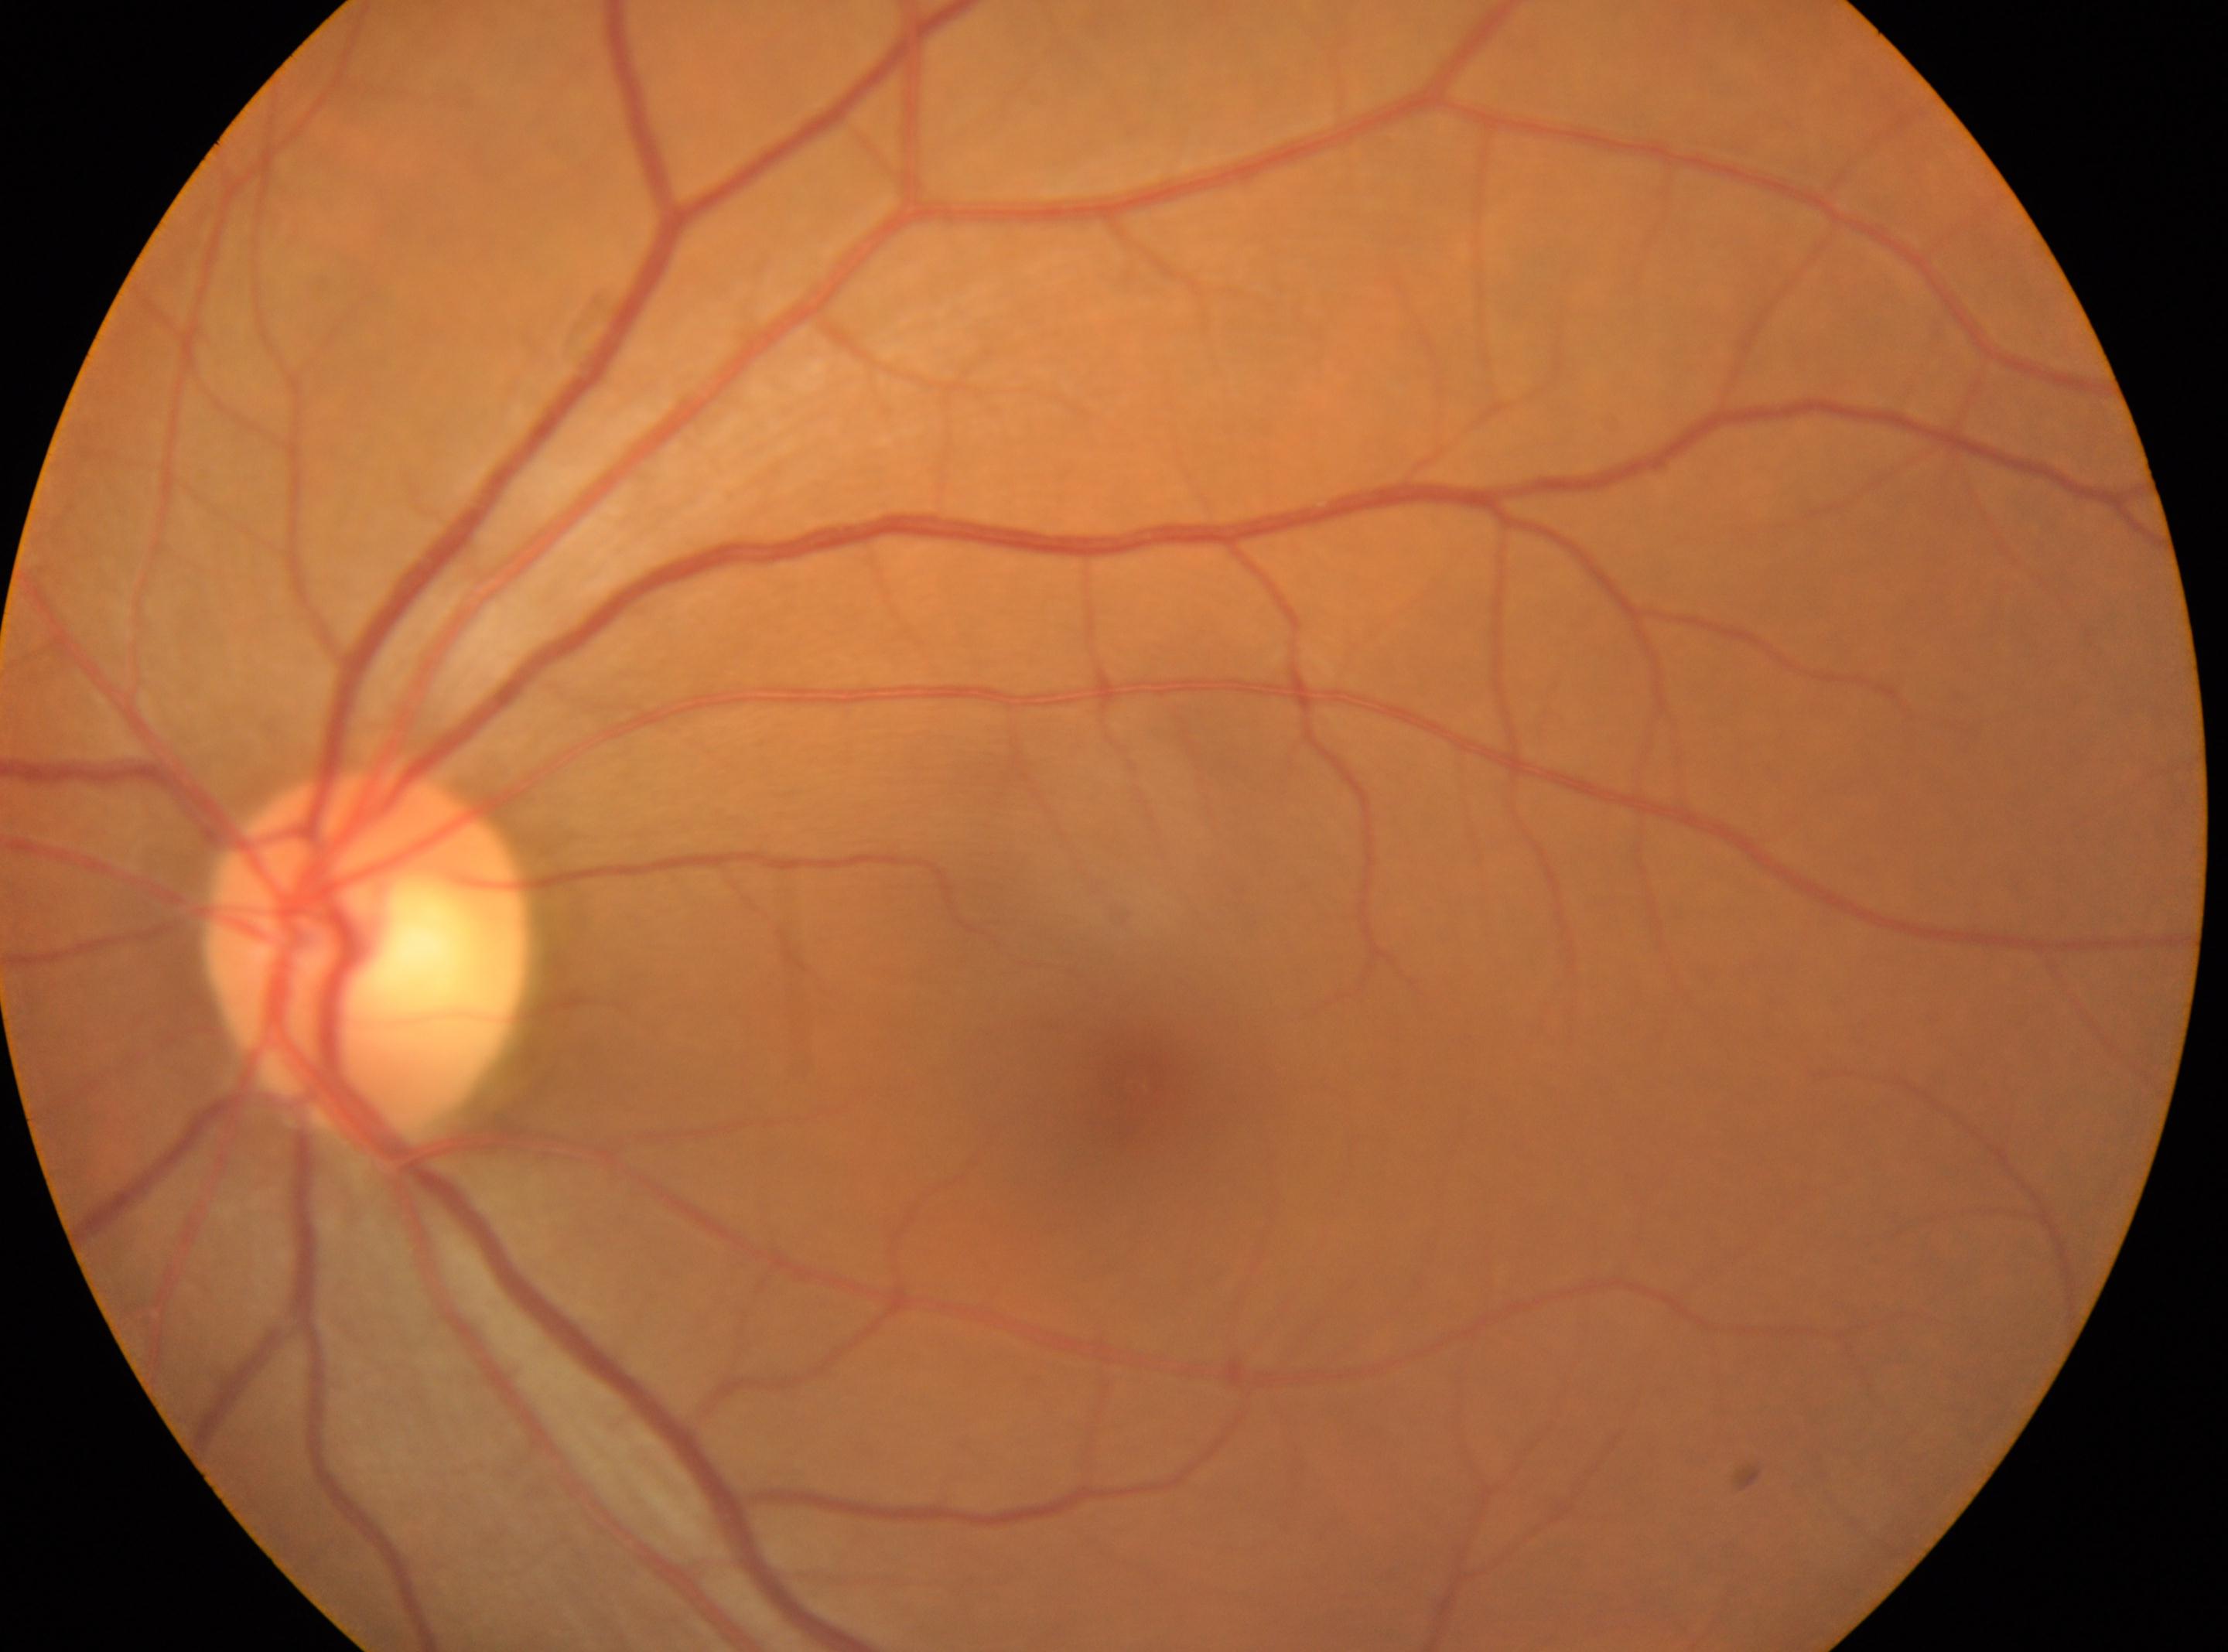
No DR findings; macula center: x=1134, y=1087; optic disk: x=362, y=956; OS; diabetic retinopathy grade: 0.